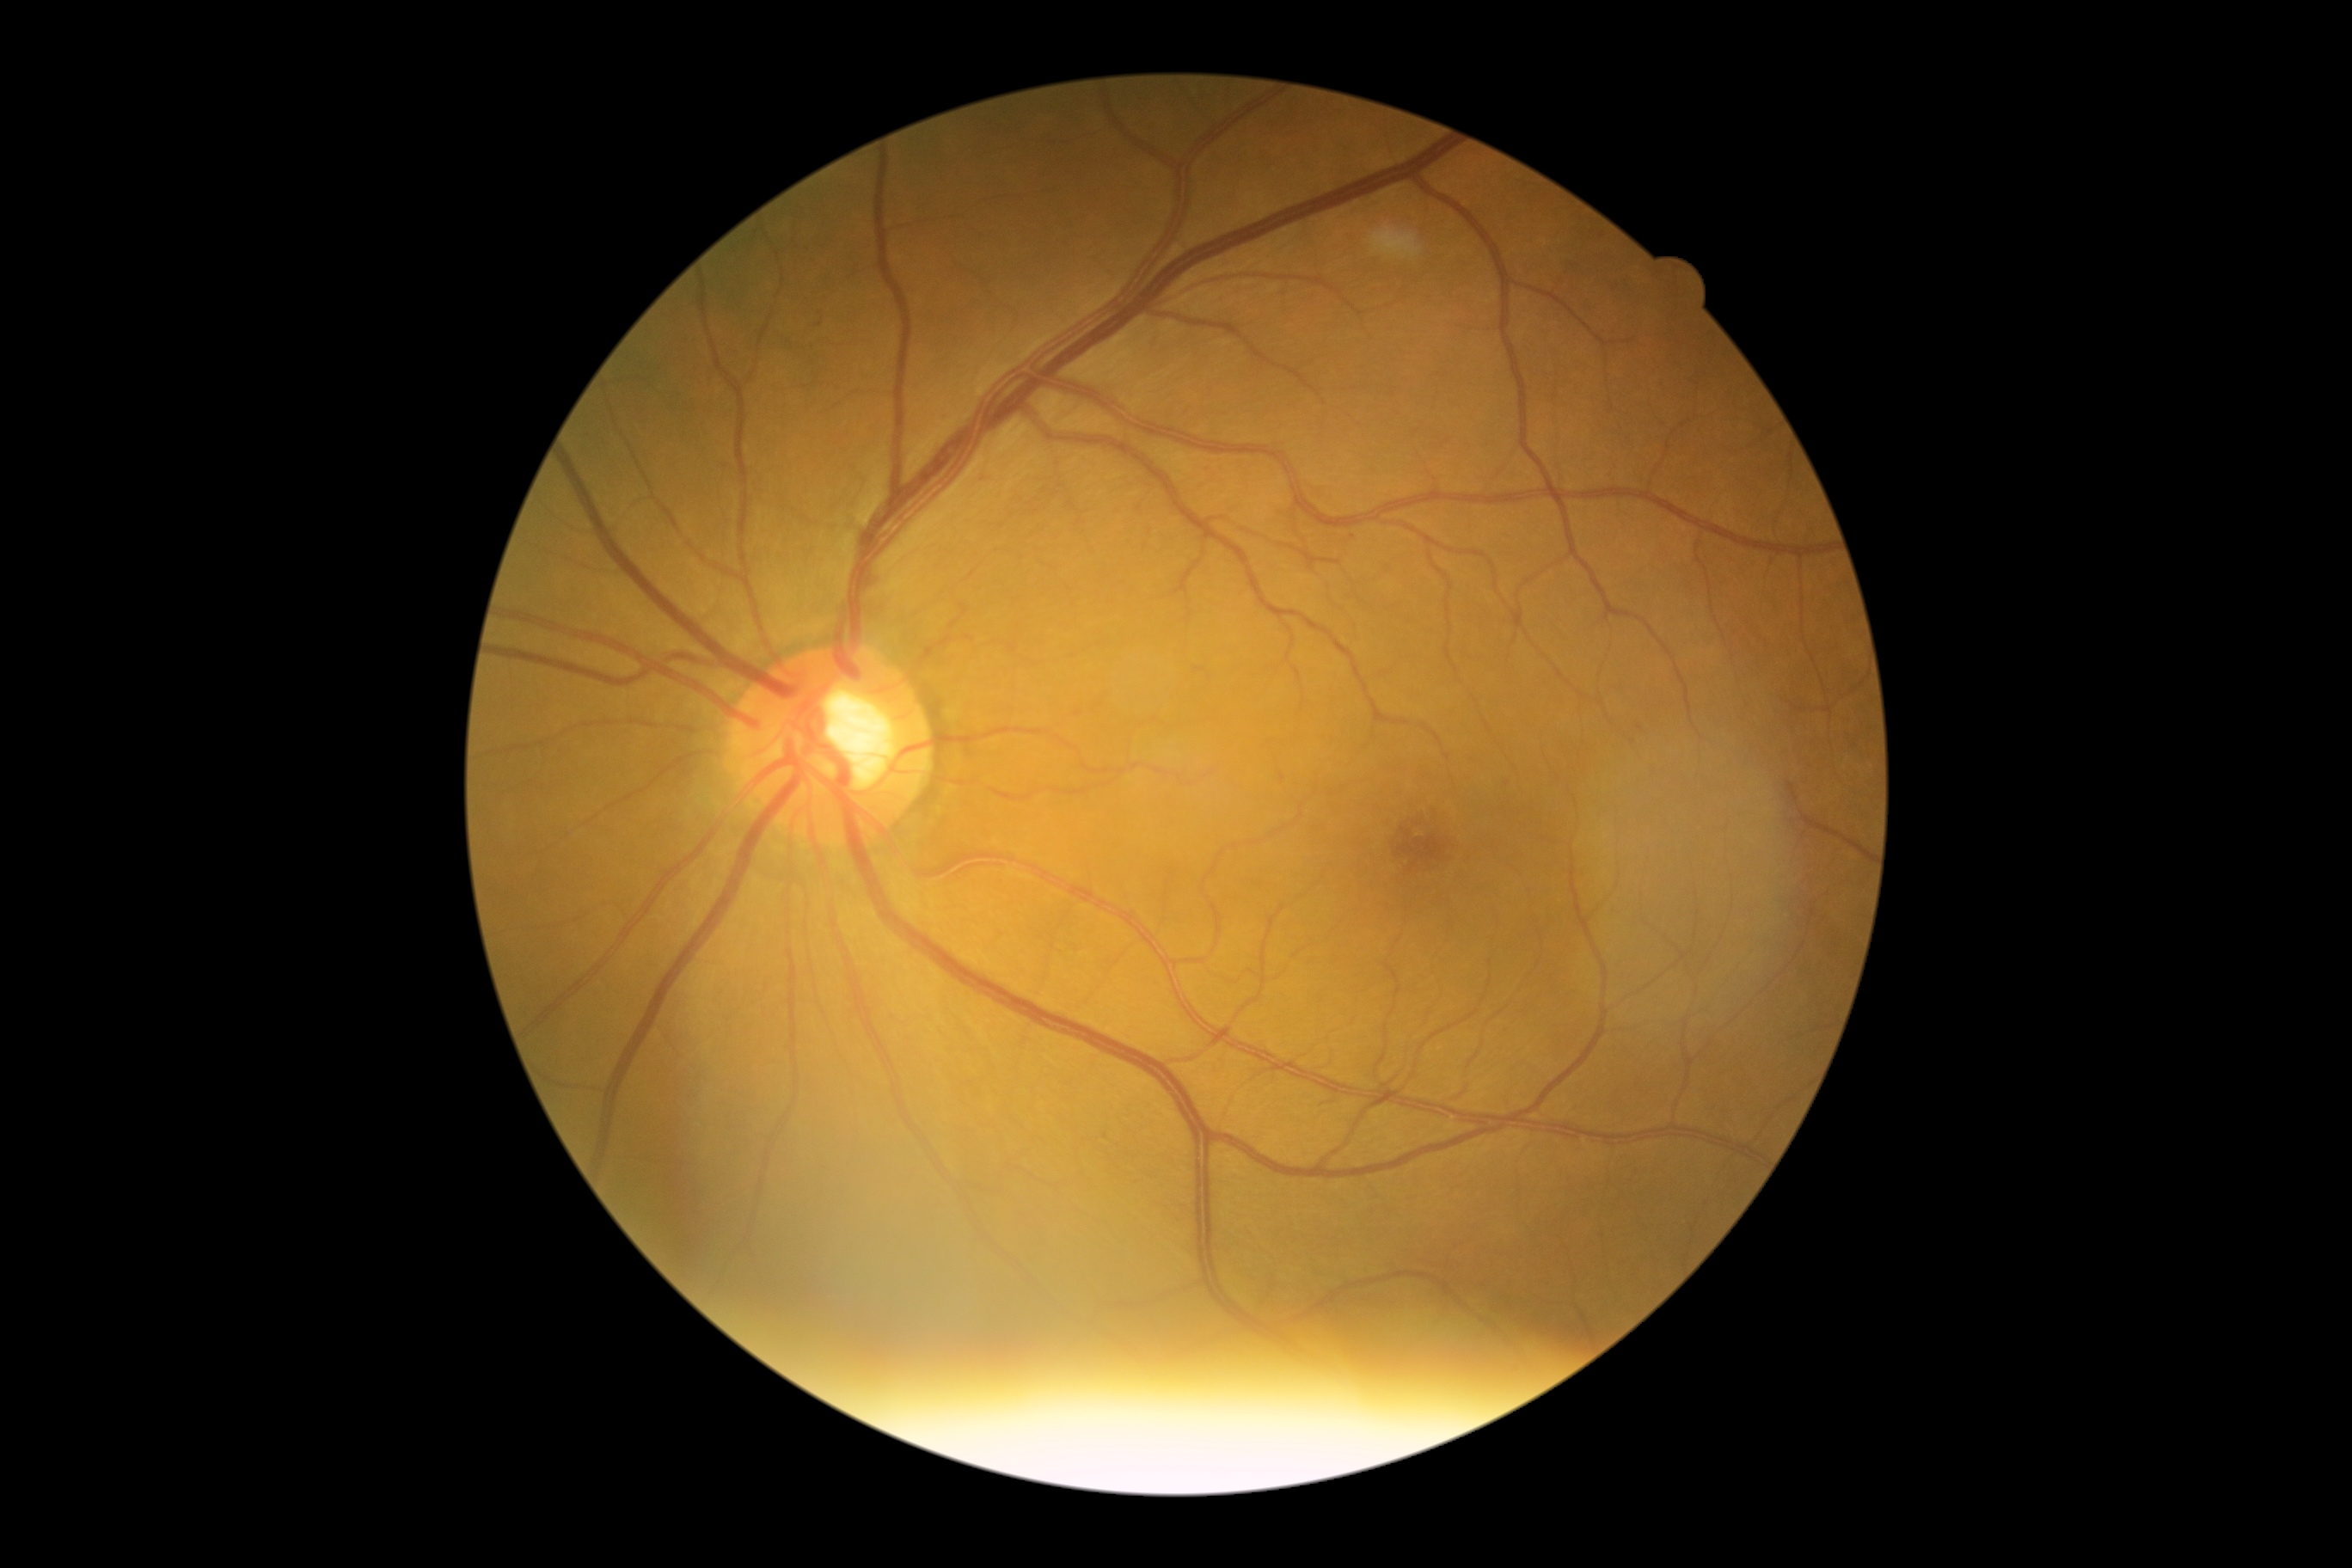 Disease class: non-proliferative diabetic retinopathy. DR stage: 1.